FOV: 45 degrees, color fundus image, 2048x1536px.
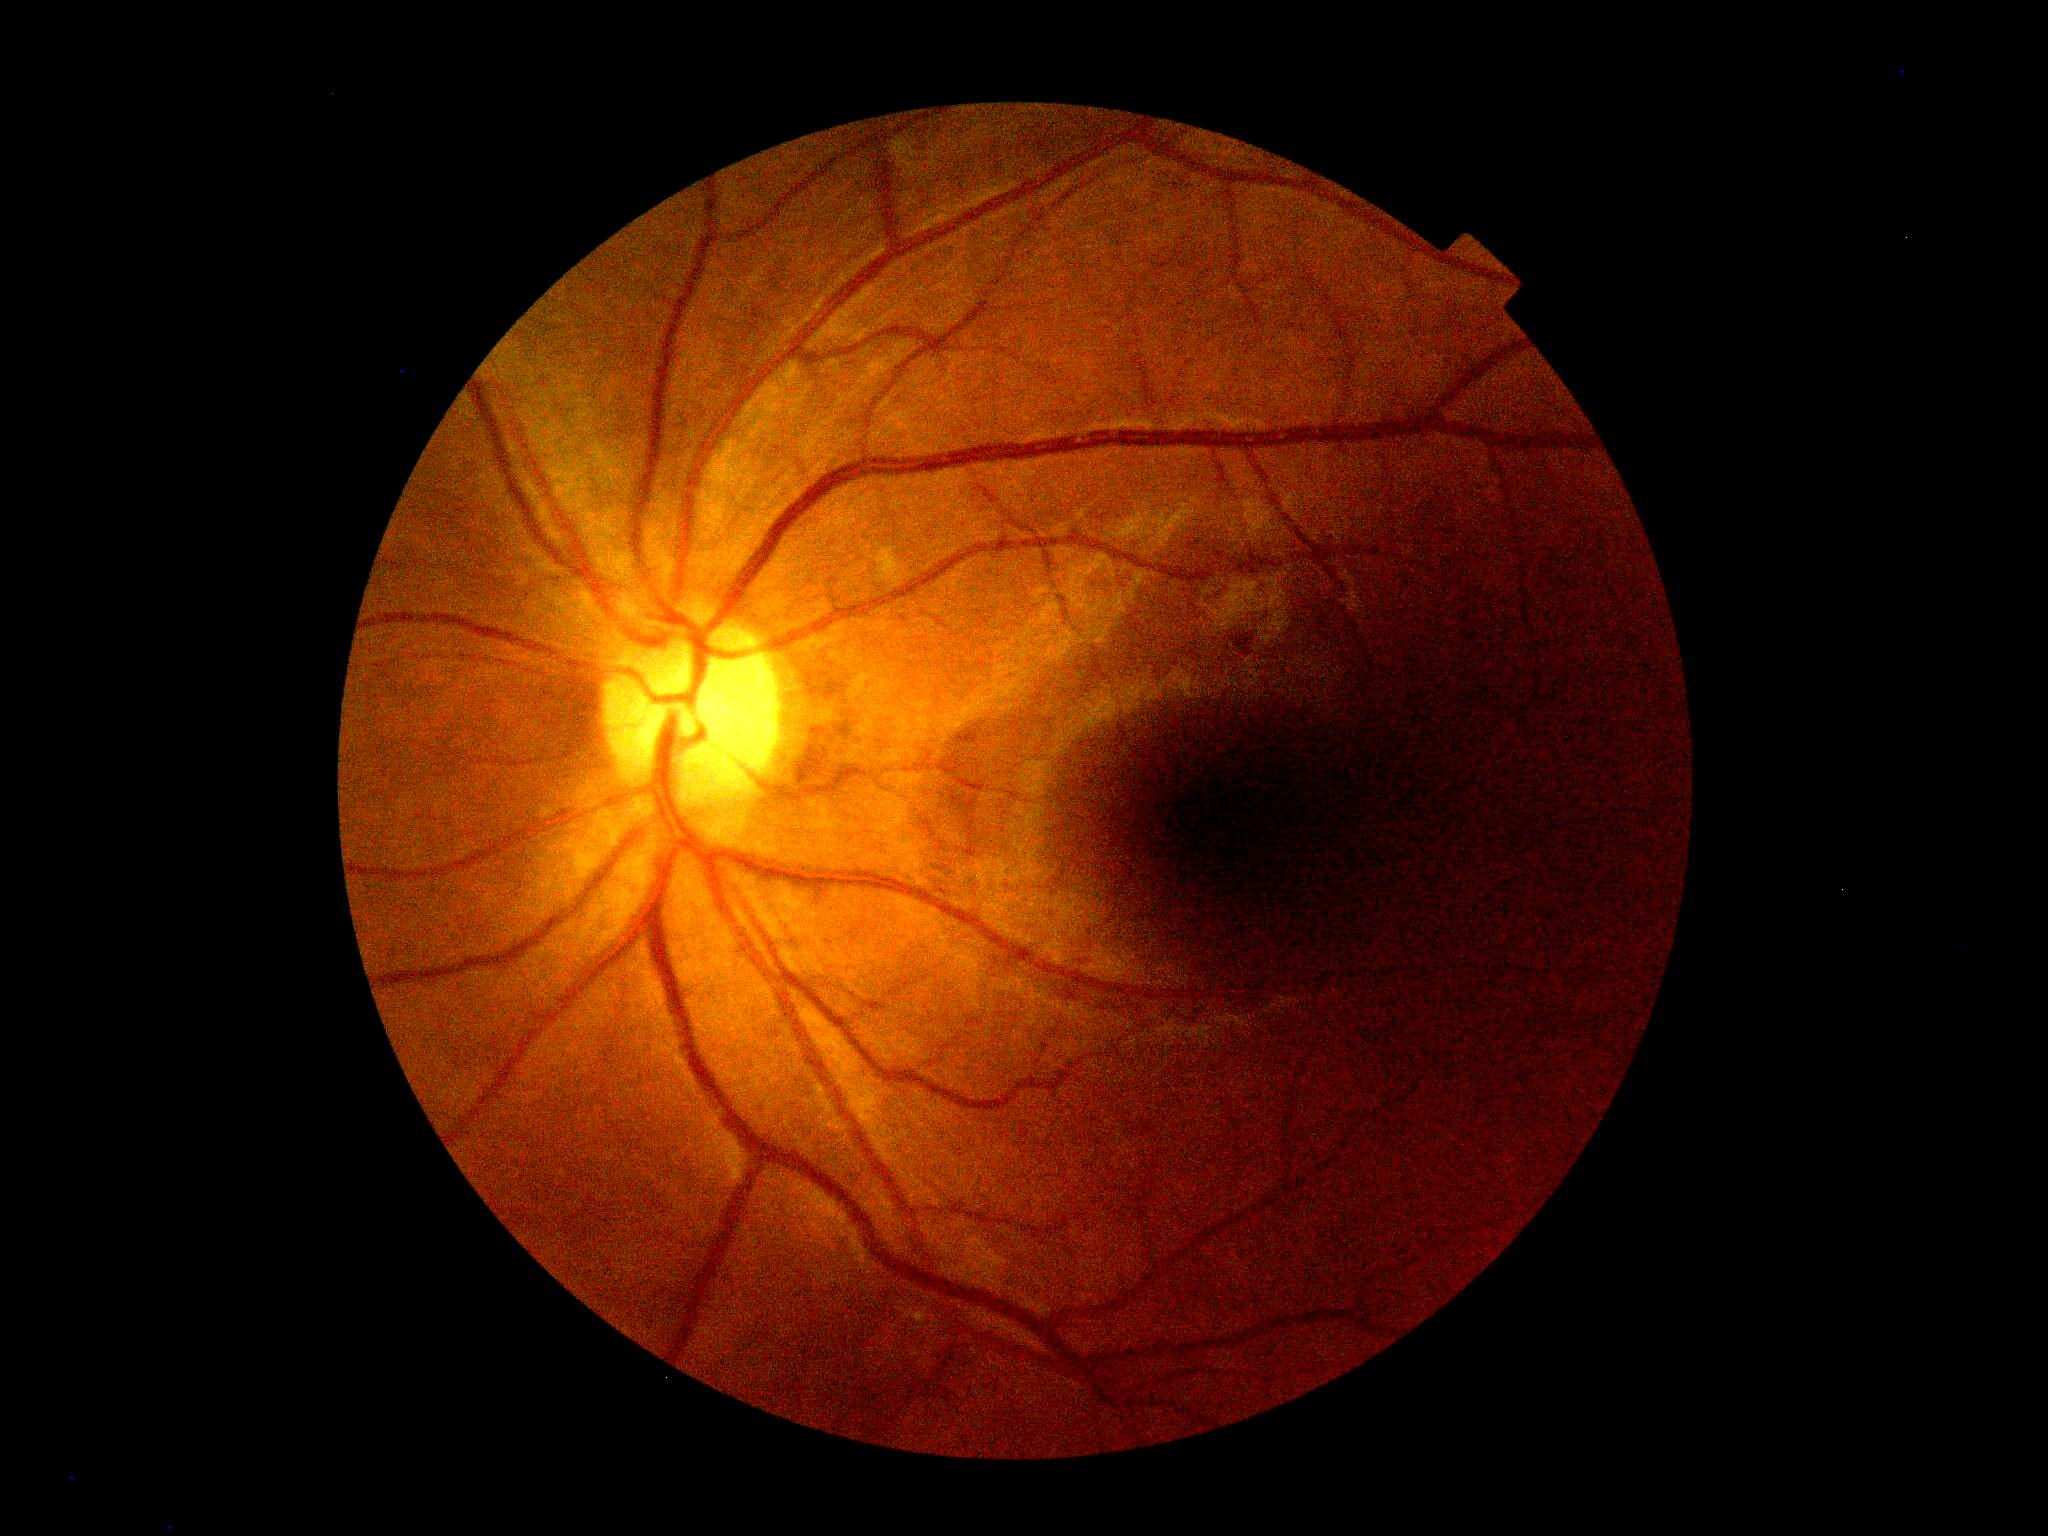
Diabetic retinopathy grade is 2 (moderate NPDR).